Image size 2102x1736:
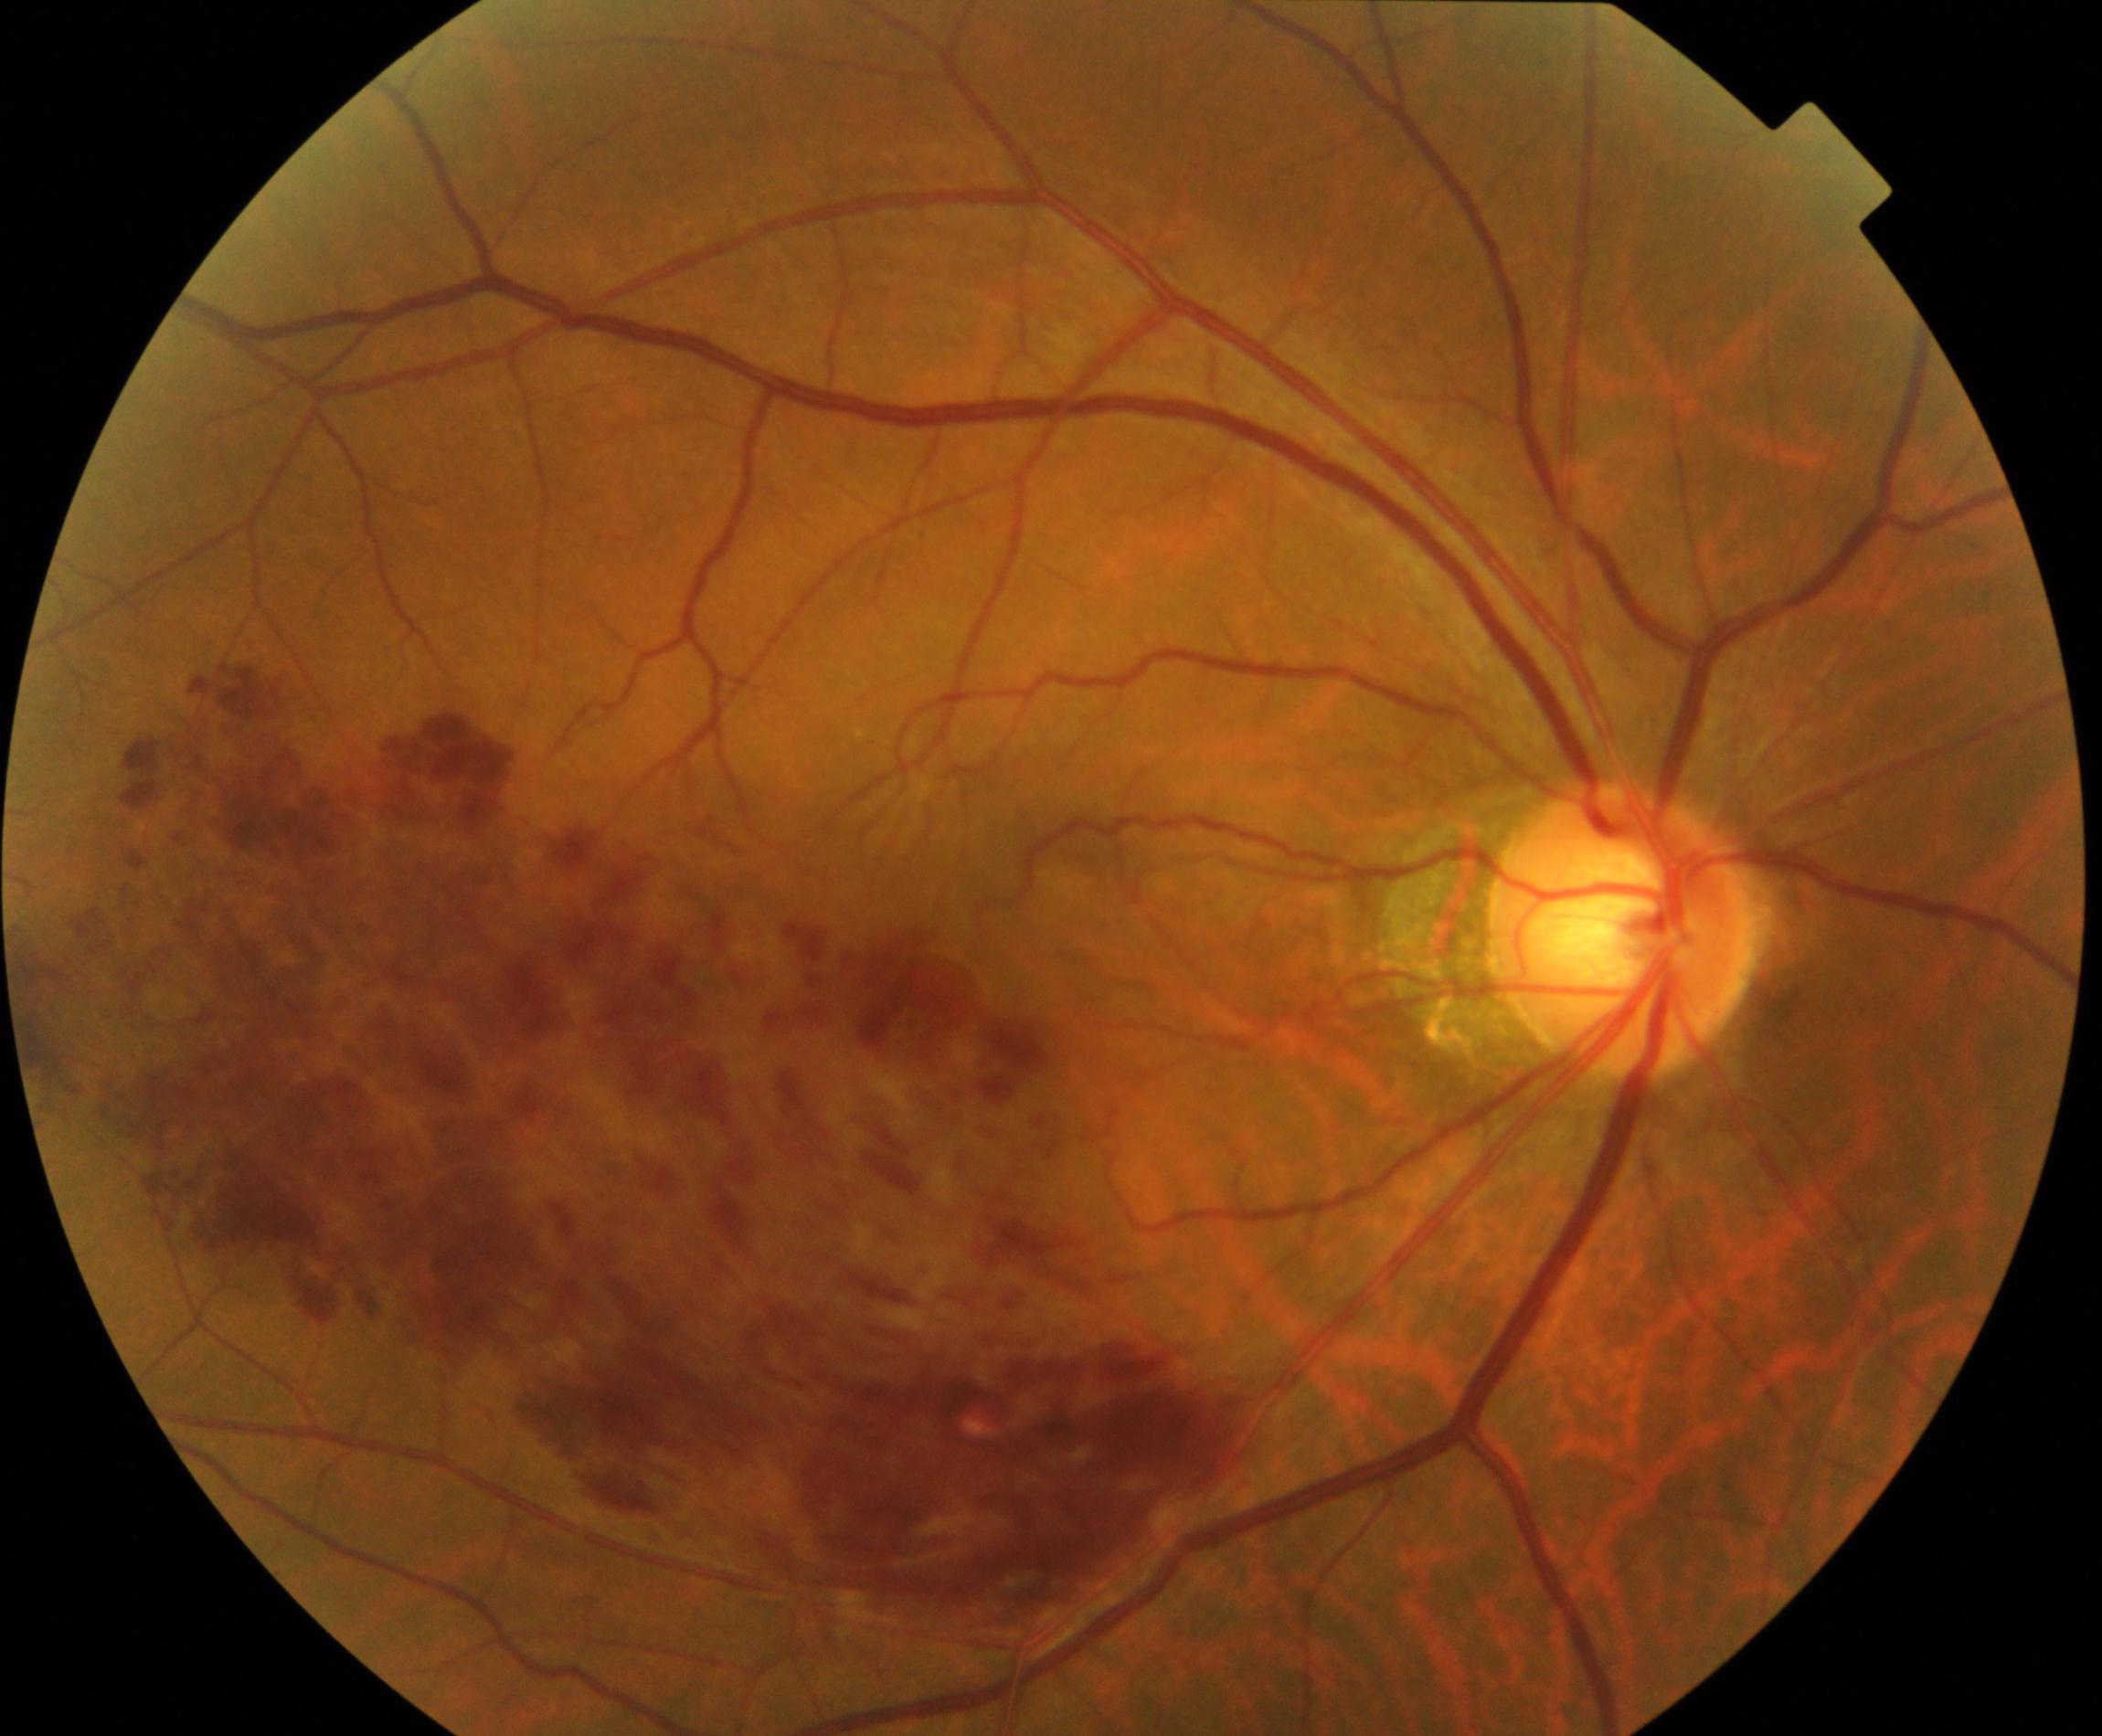 Impression: BRVO (branch retinal vein occlusion). Typically showing tortuosity and dilatation of affected veins, with dot, blot, and flame hemorrhages, sometimes with cotton-wool spots or hard exudates.